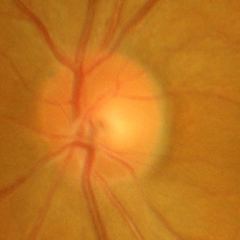
Glaucomatous changes are present. Findings consistent with early glaucomatous changes.